Mydriatic (tropicamide 0.5%) · color fundus photograph · 50-degree field of view.
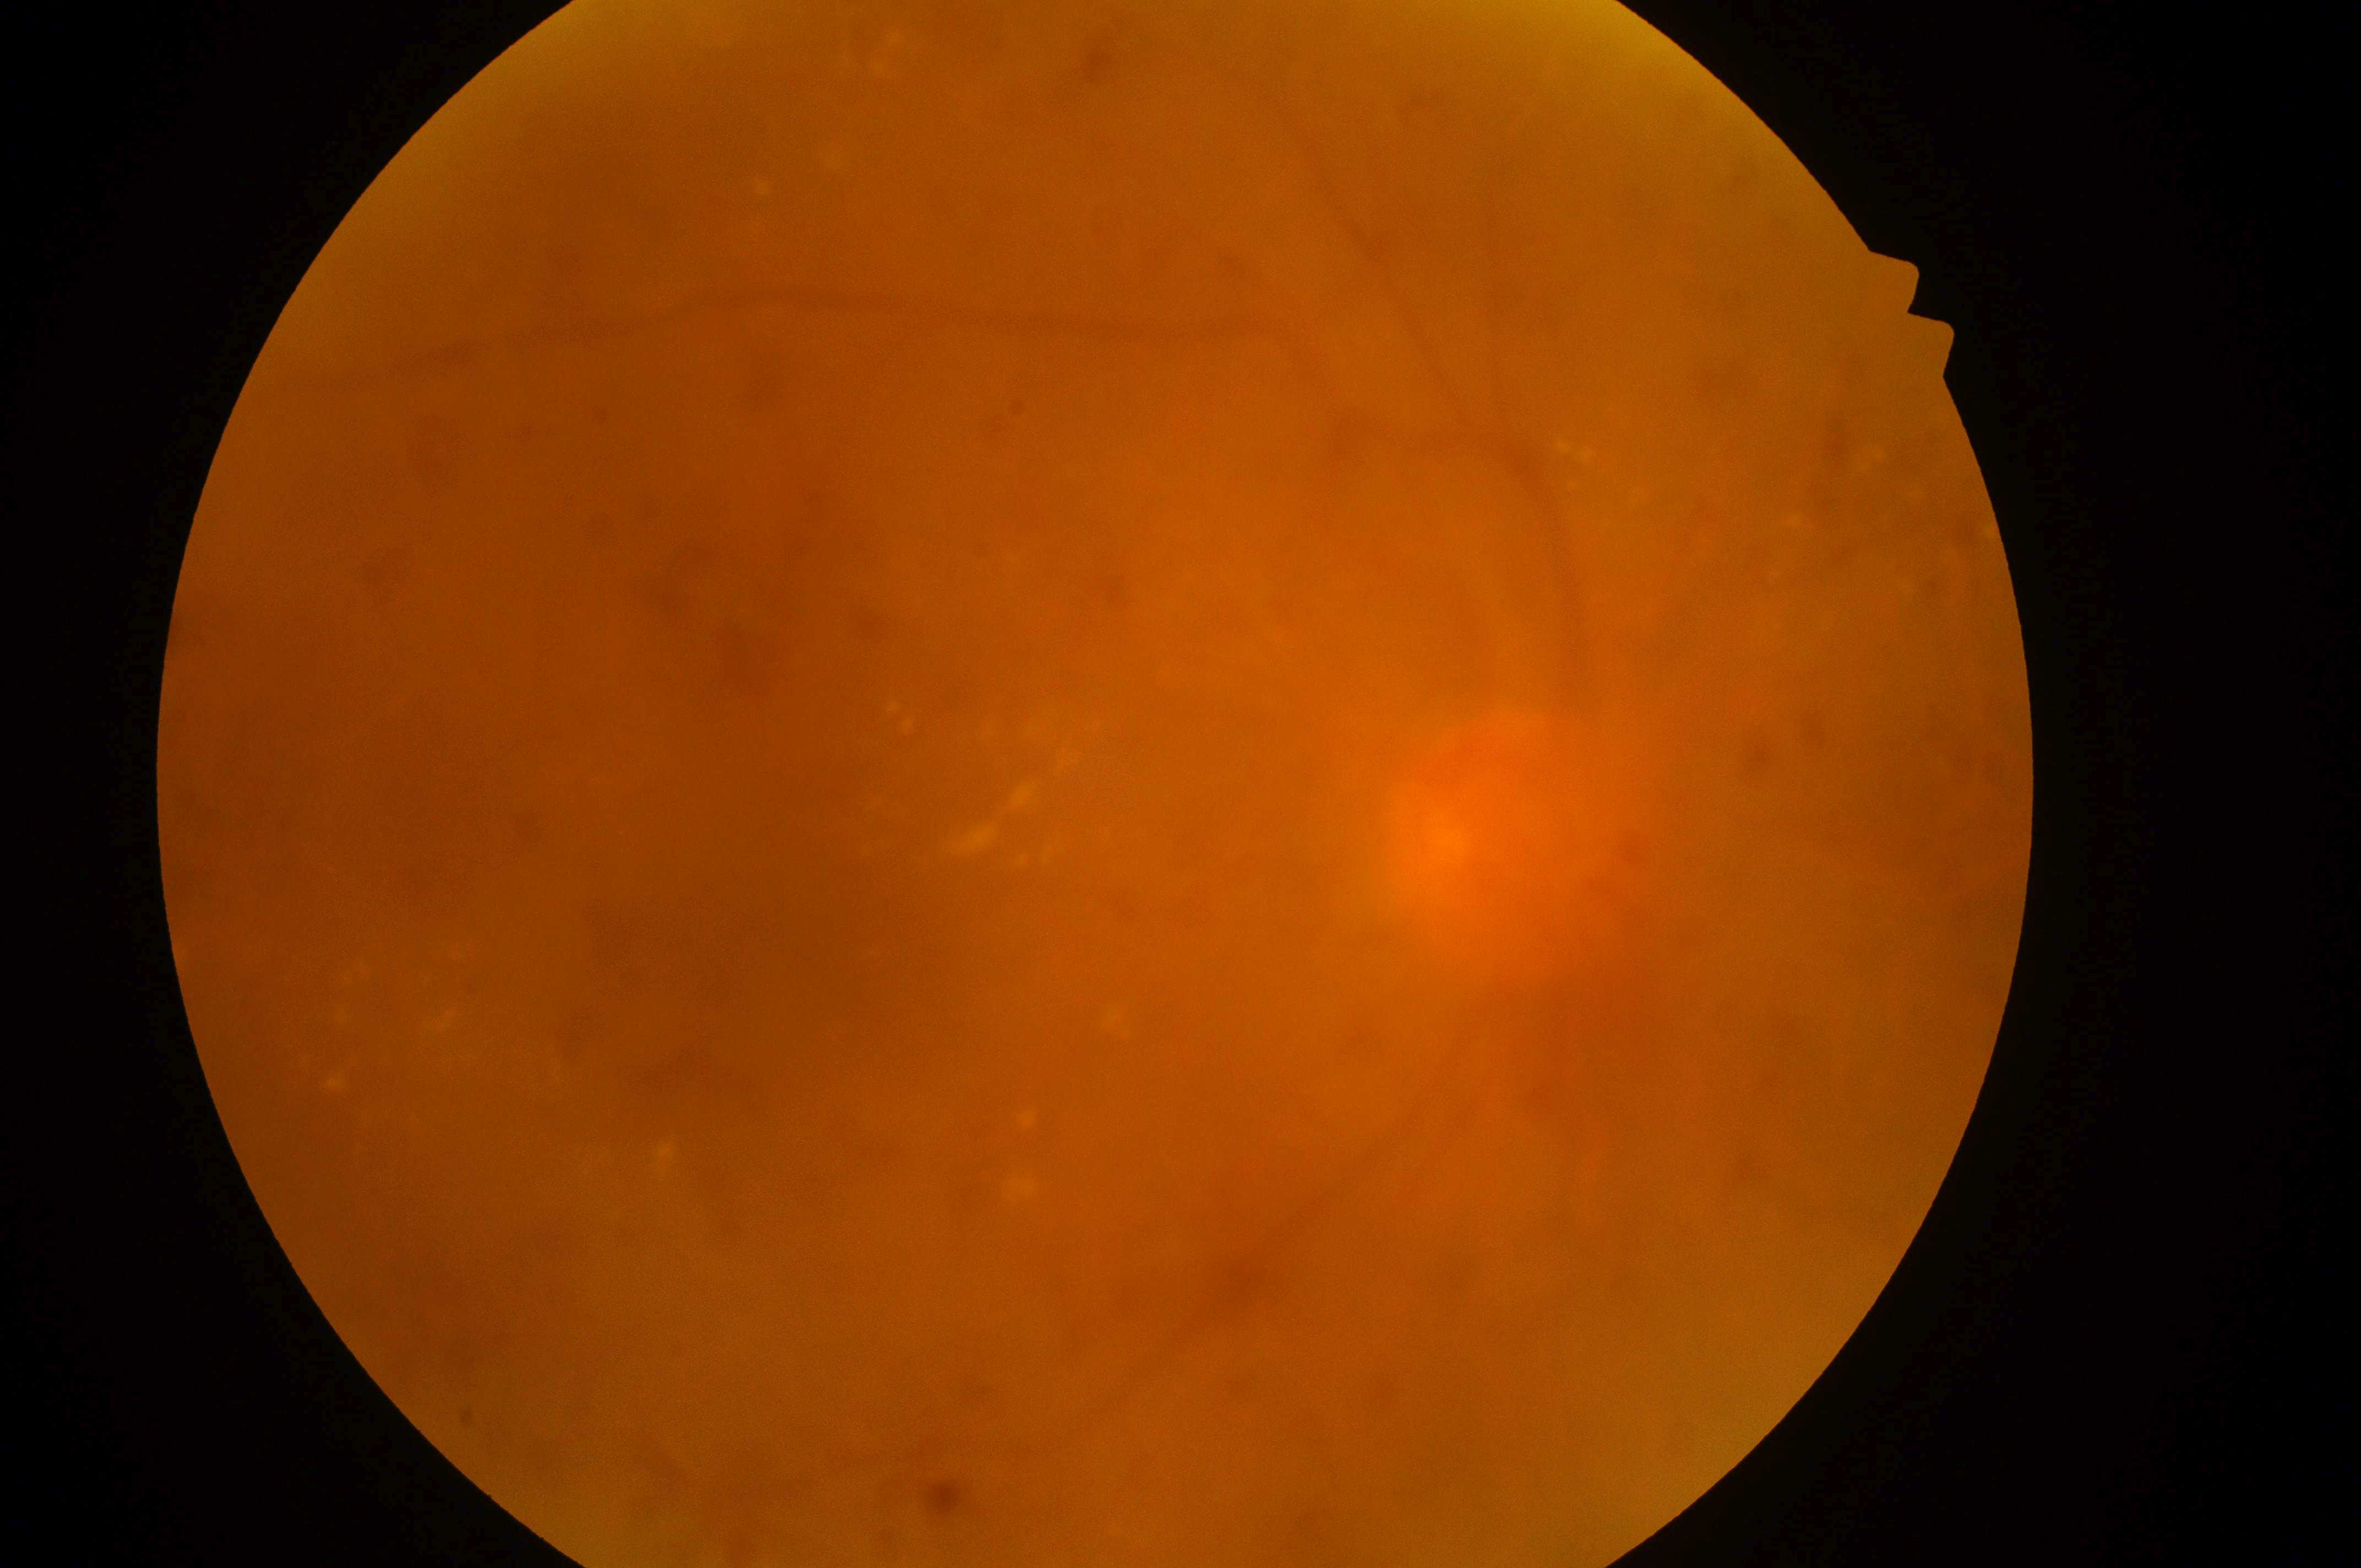
The fovea centralis is at 810px, 963px.
Imaged eye: the right eye.
Diabetic retinopathy grade is 4/4.
Diabetic macular edema is grade 2.
Optic disk located at 1516px, 856px.